CFP · camera: NIDEK AFC-230 · diabetic retinopathy graded by the modified Davis classification:
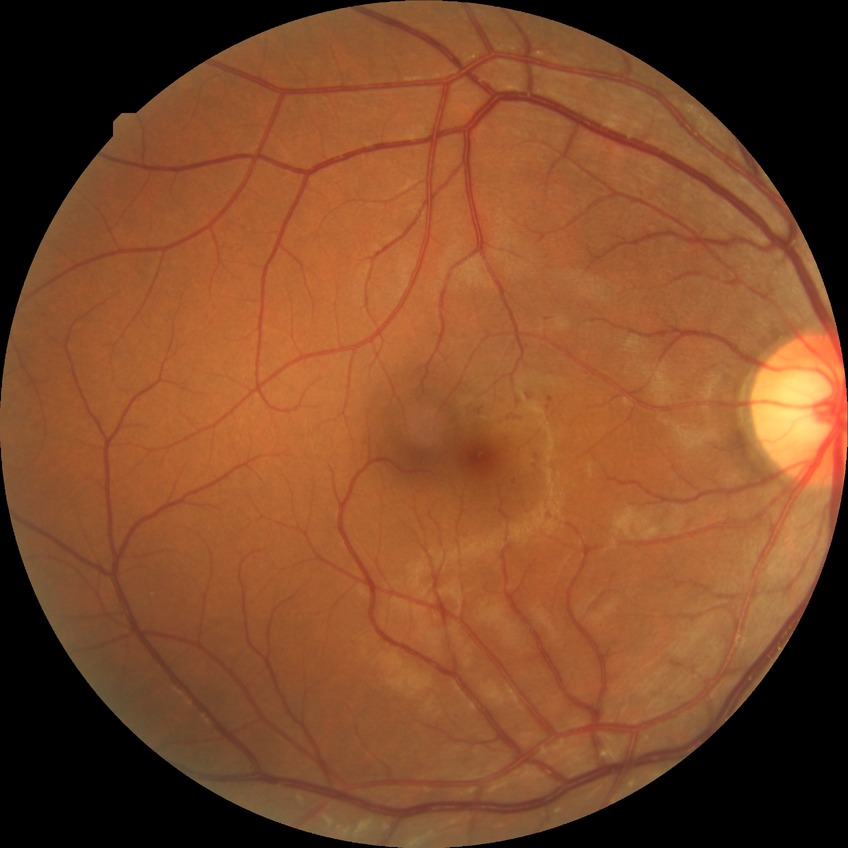

Diabetic retinopathy (DR): simple diabetic retinopathy (SDR). DR class: non-proliferative diabetic retinopathy.